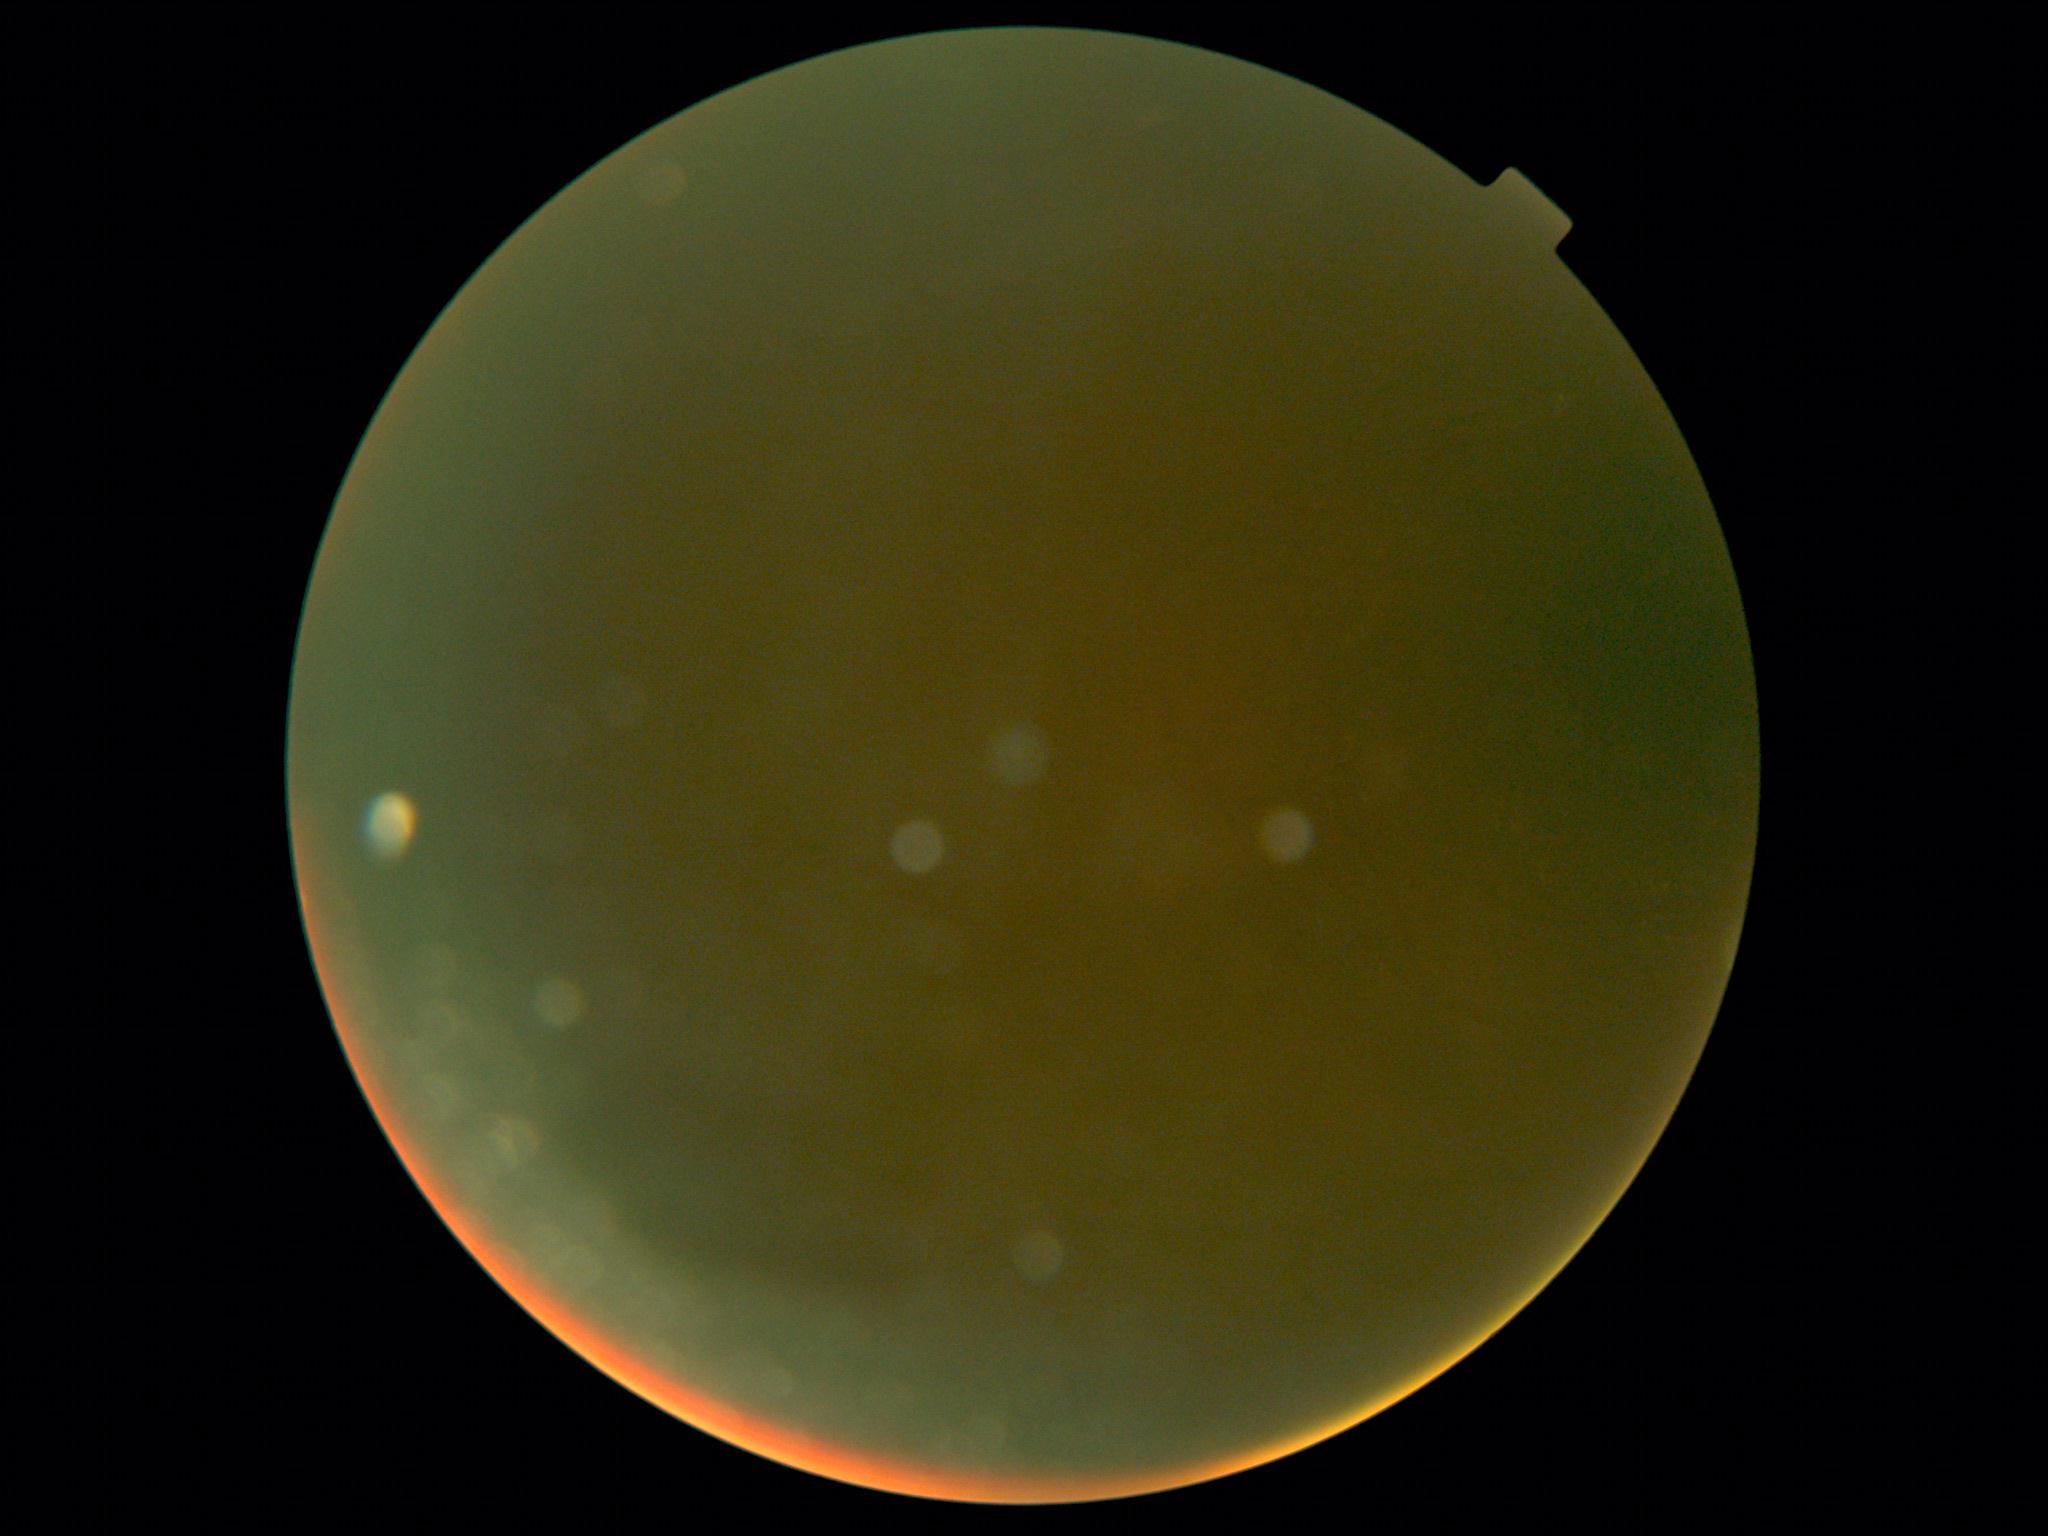
Annotations:
• diabetic retinopathy — ungradable due to poor image quality